45° field of view · color fundus image.
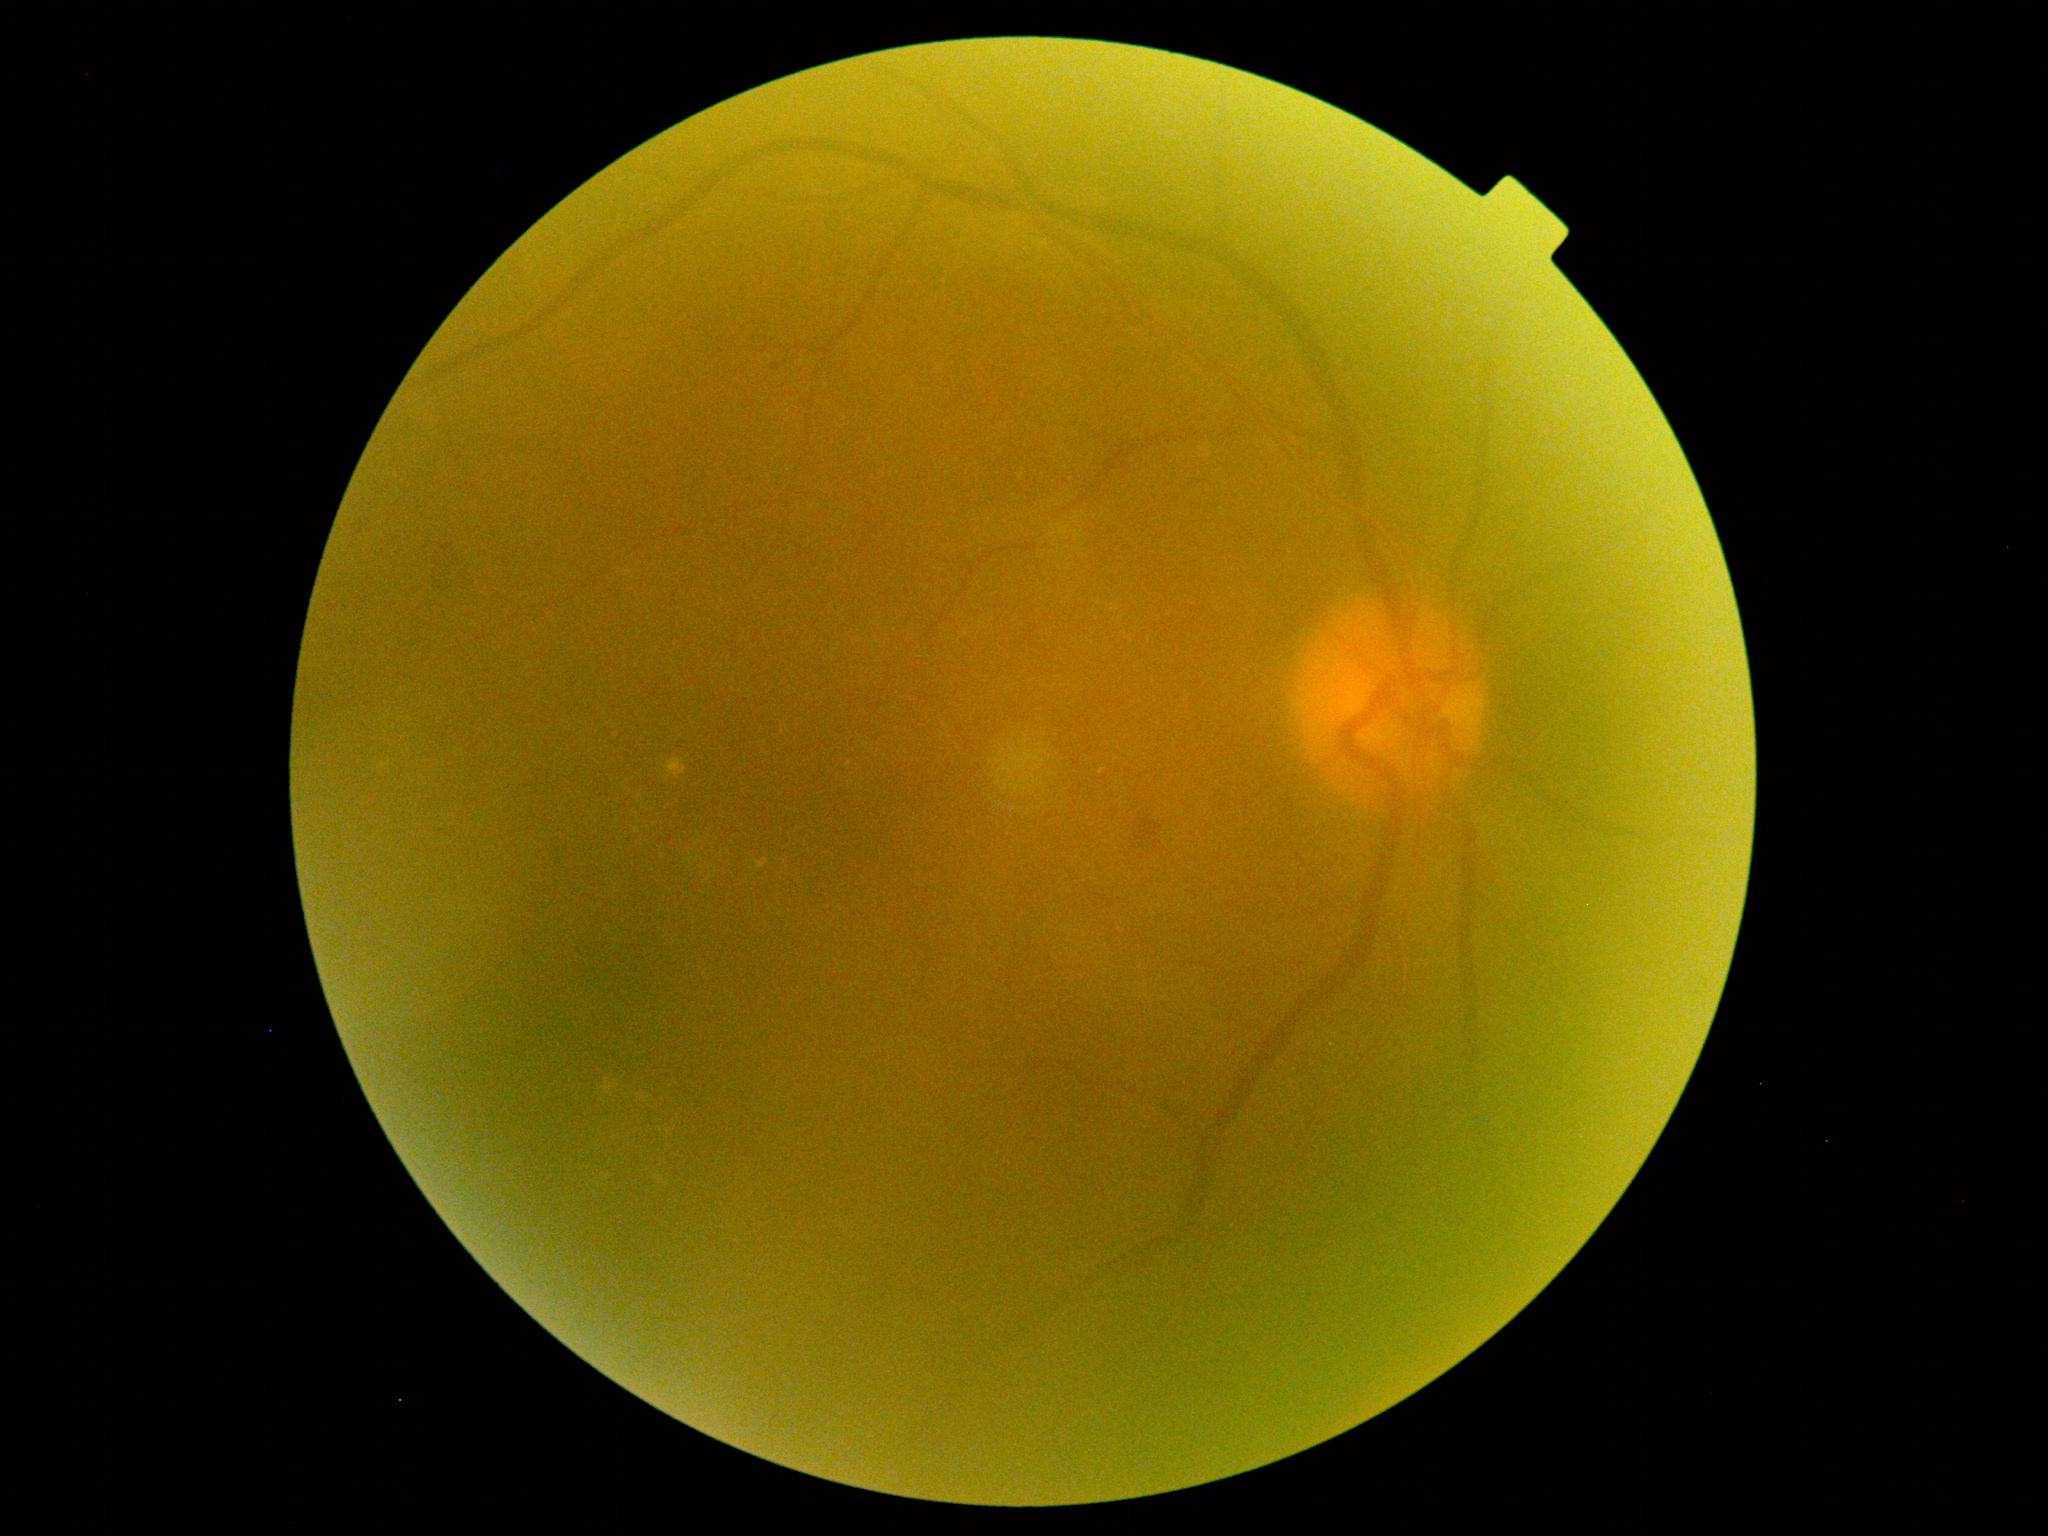
Annotations:
- DR grade: 2